45-degree field of view · 2212x1659px: 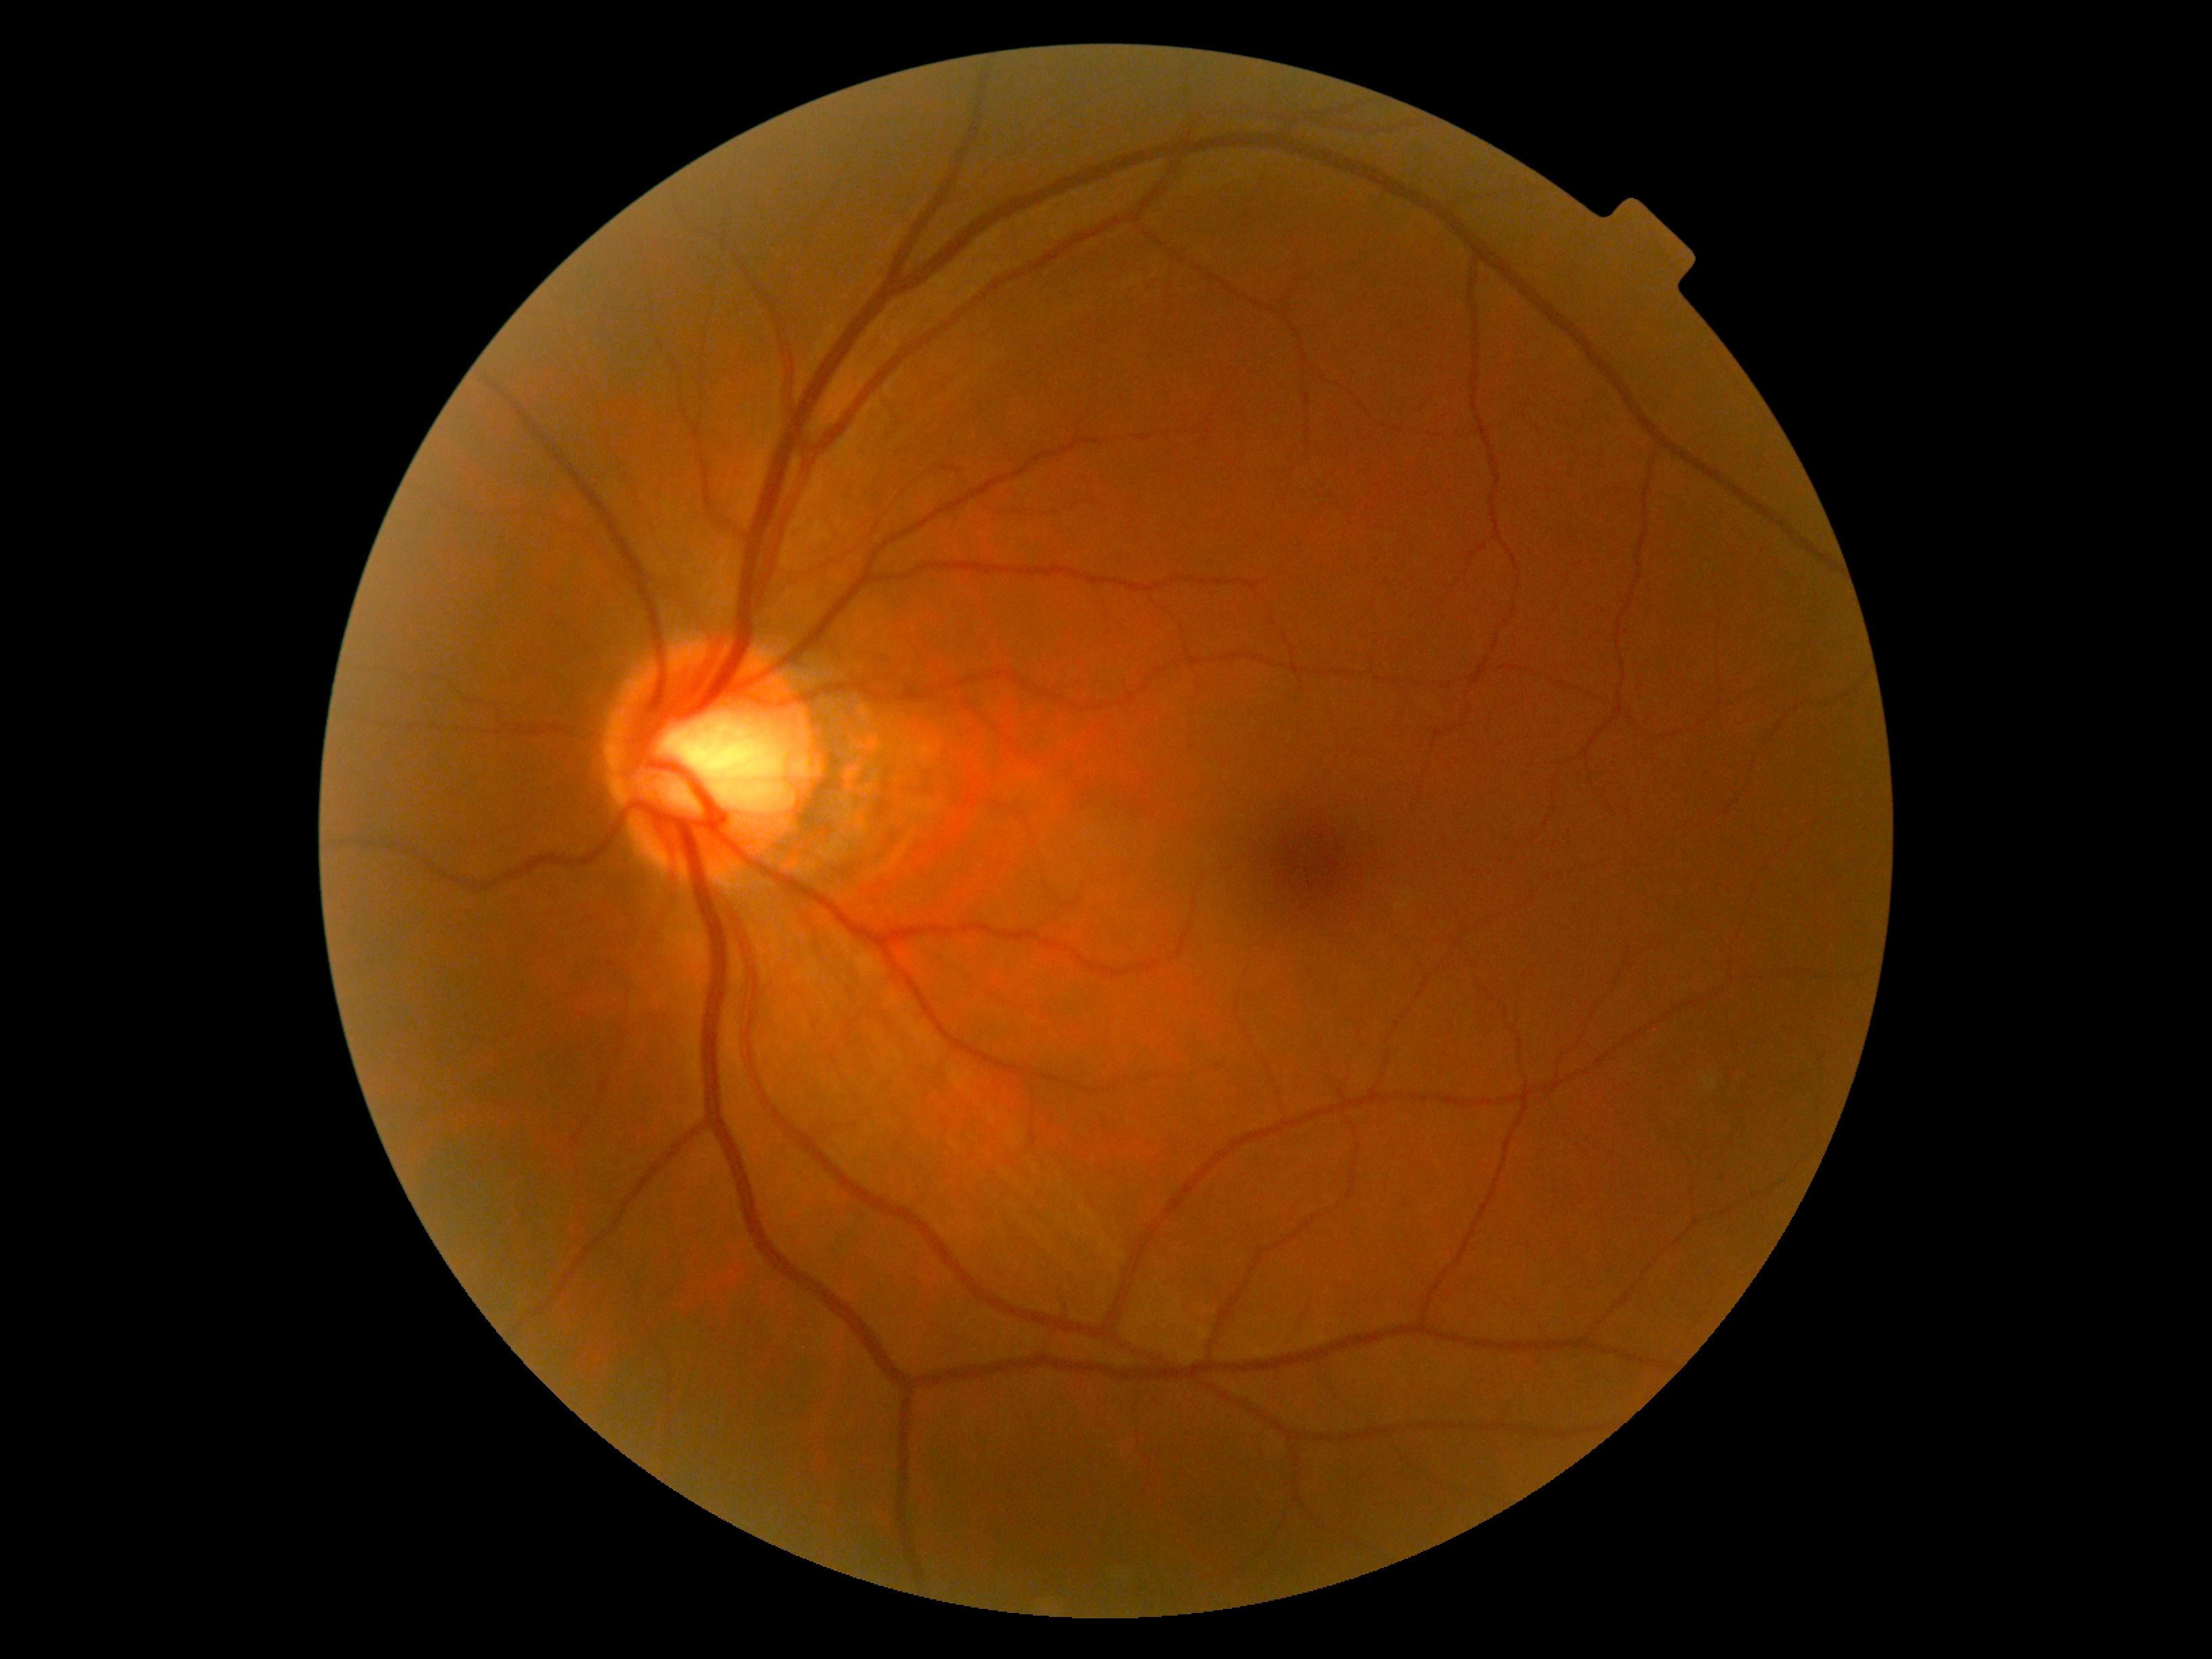
No diabetic retinal disease findings. Diabetic retinopathy severity: 0/4.